Image size 2102x1736 — 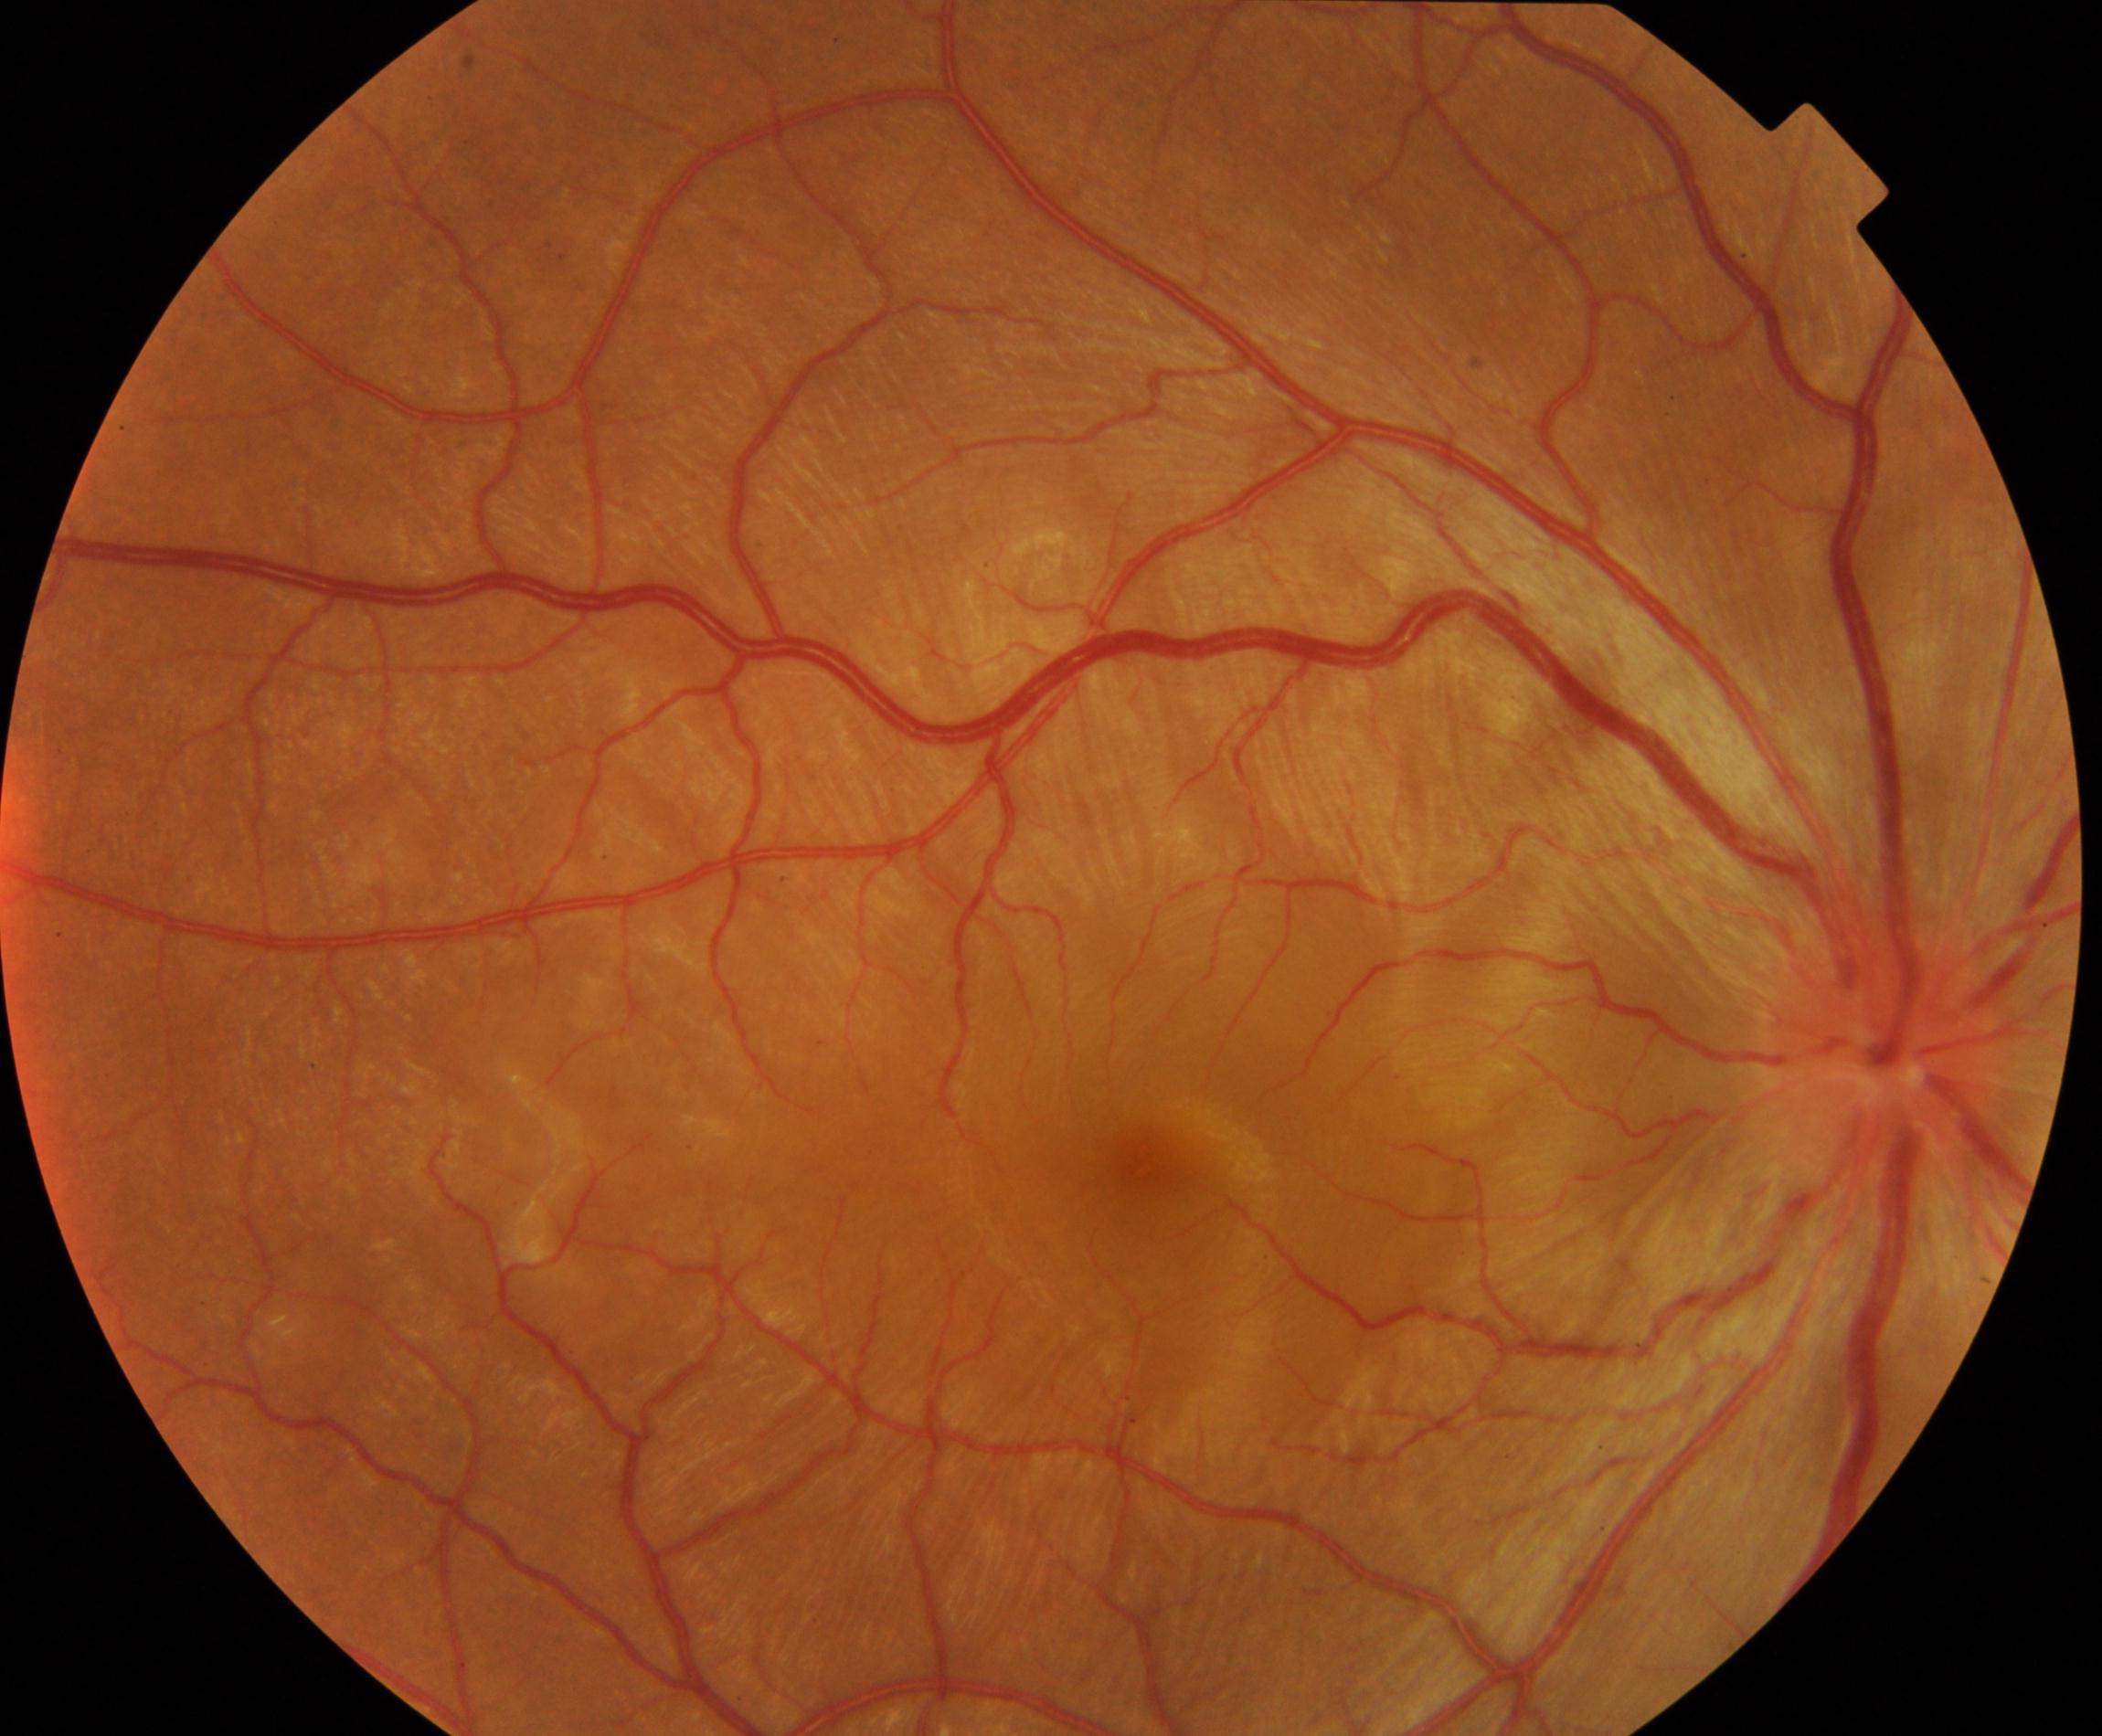

Findings consistent with Vogt-Koyanagi-Harada disease.